Retinal fundus photograph
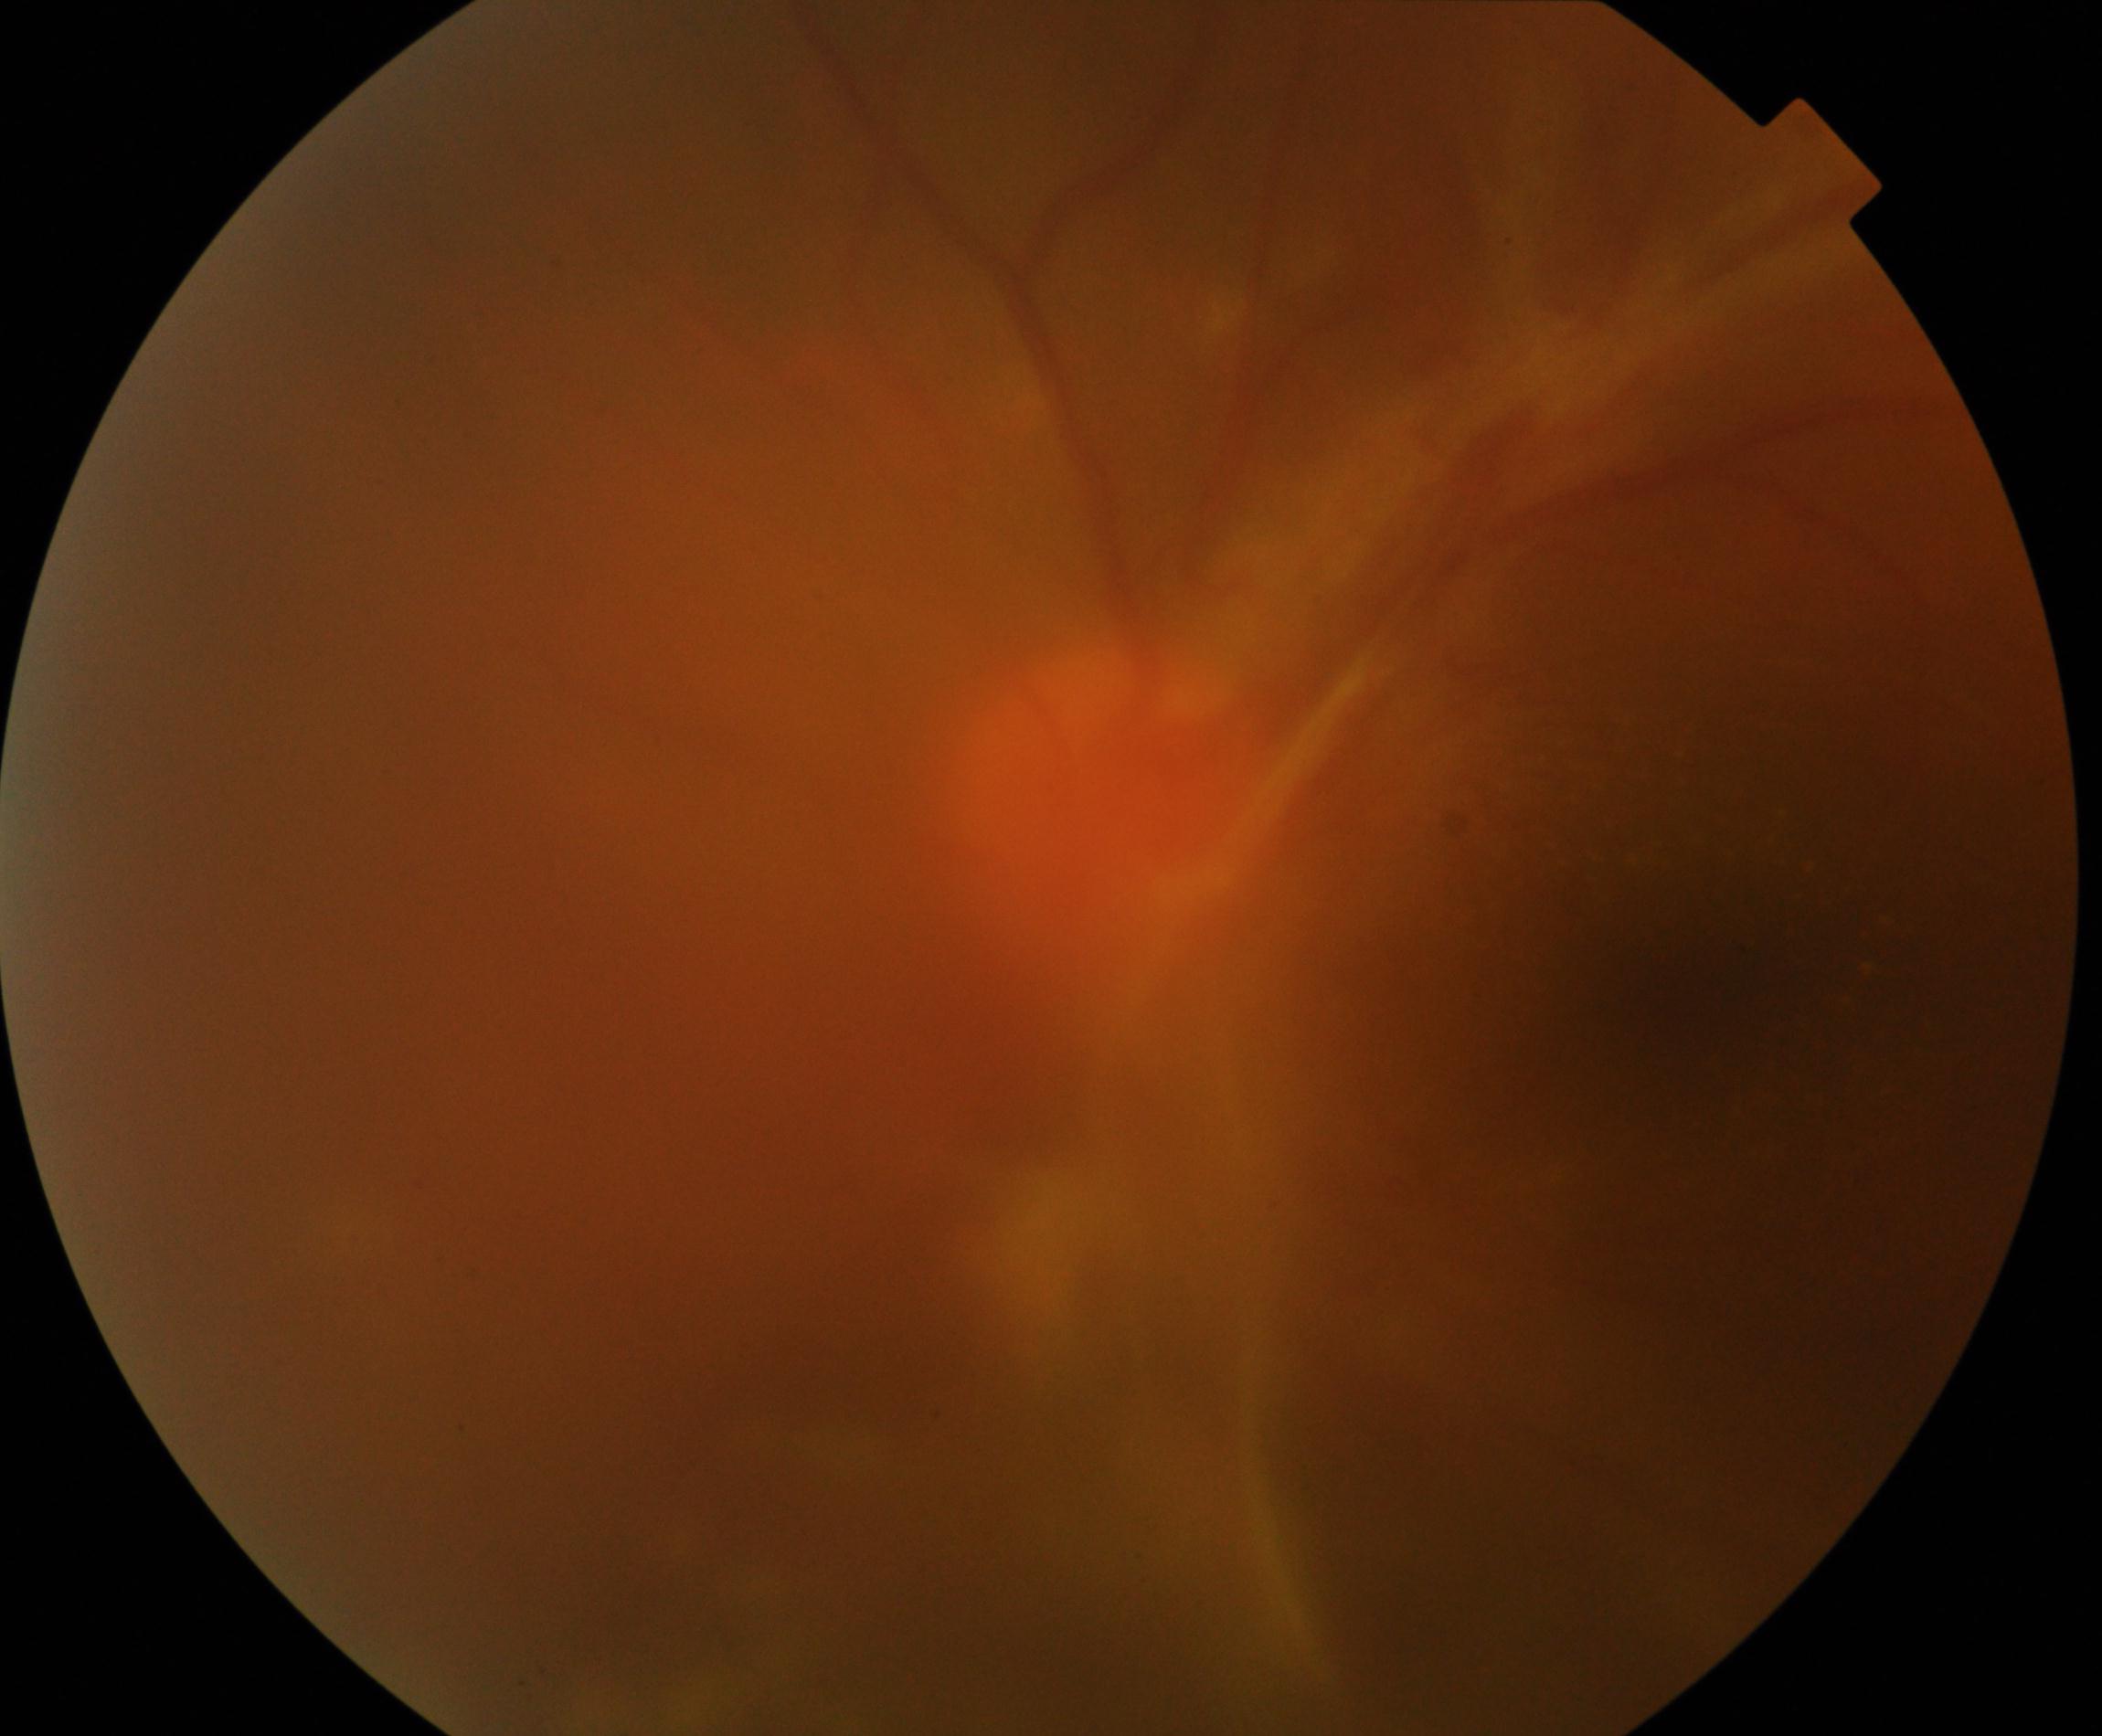 Image is blurred; retinal landmarks are largely obscured. Features suspicious for proliferative diabetic retinopathy.